130° field of view (Clarity RetCam 3) · pediatric retinal photograph (wide-field): 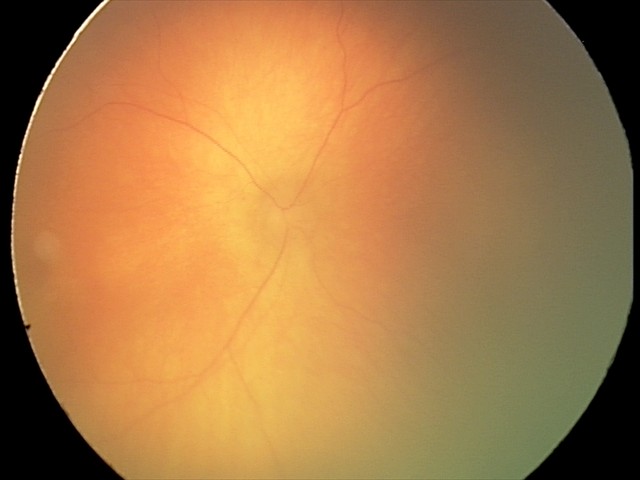

Diagnosis = ROP stage 0.